45-degree field of view; 2144x1424 — 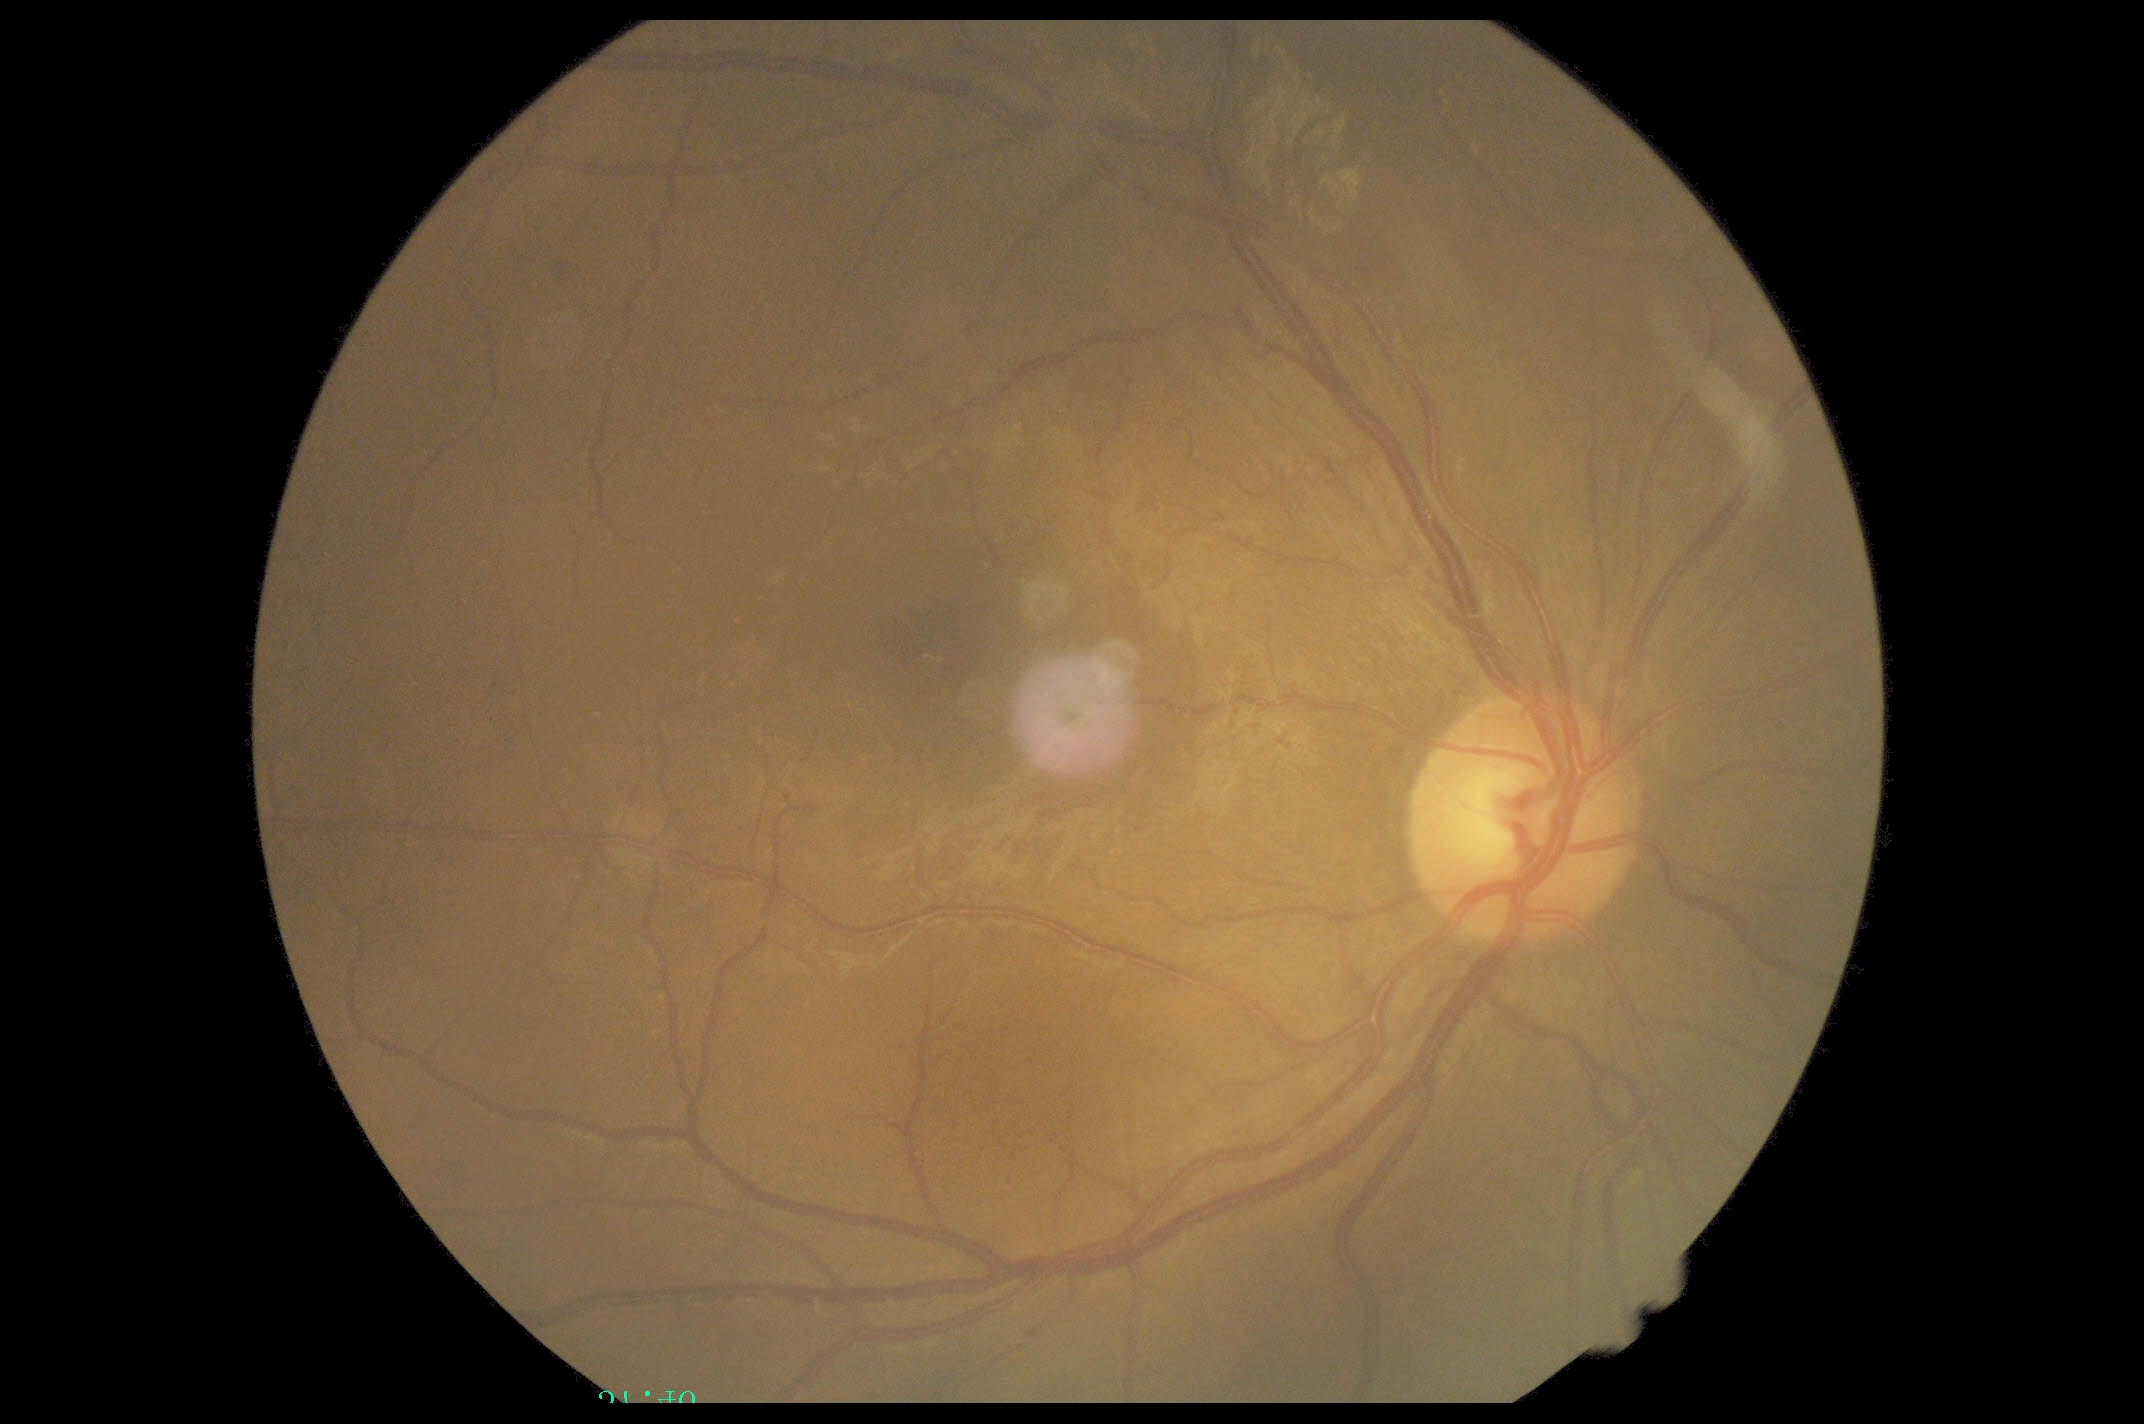
diabetic retinopathy severity=moderate NPDR (grade 2) — more than just microaneurysms but less than severe NPDR.